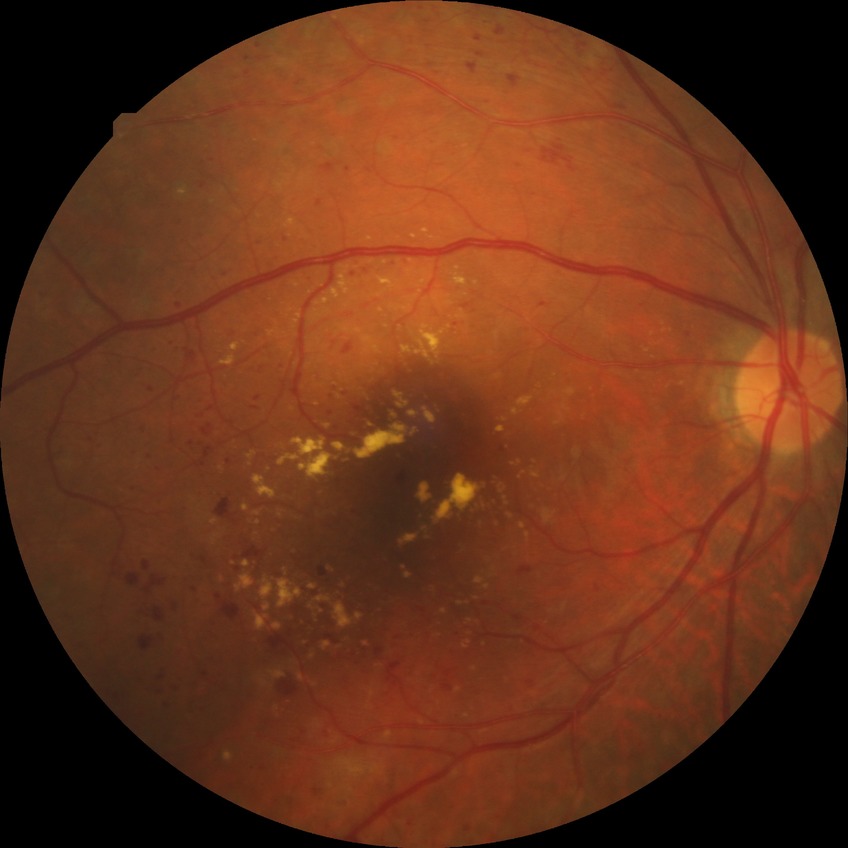

  davis_grade: PDR (proliferative diabetic retinopathy)